Acquired with a Remidio smartphone fundus camera
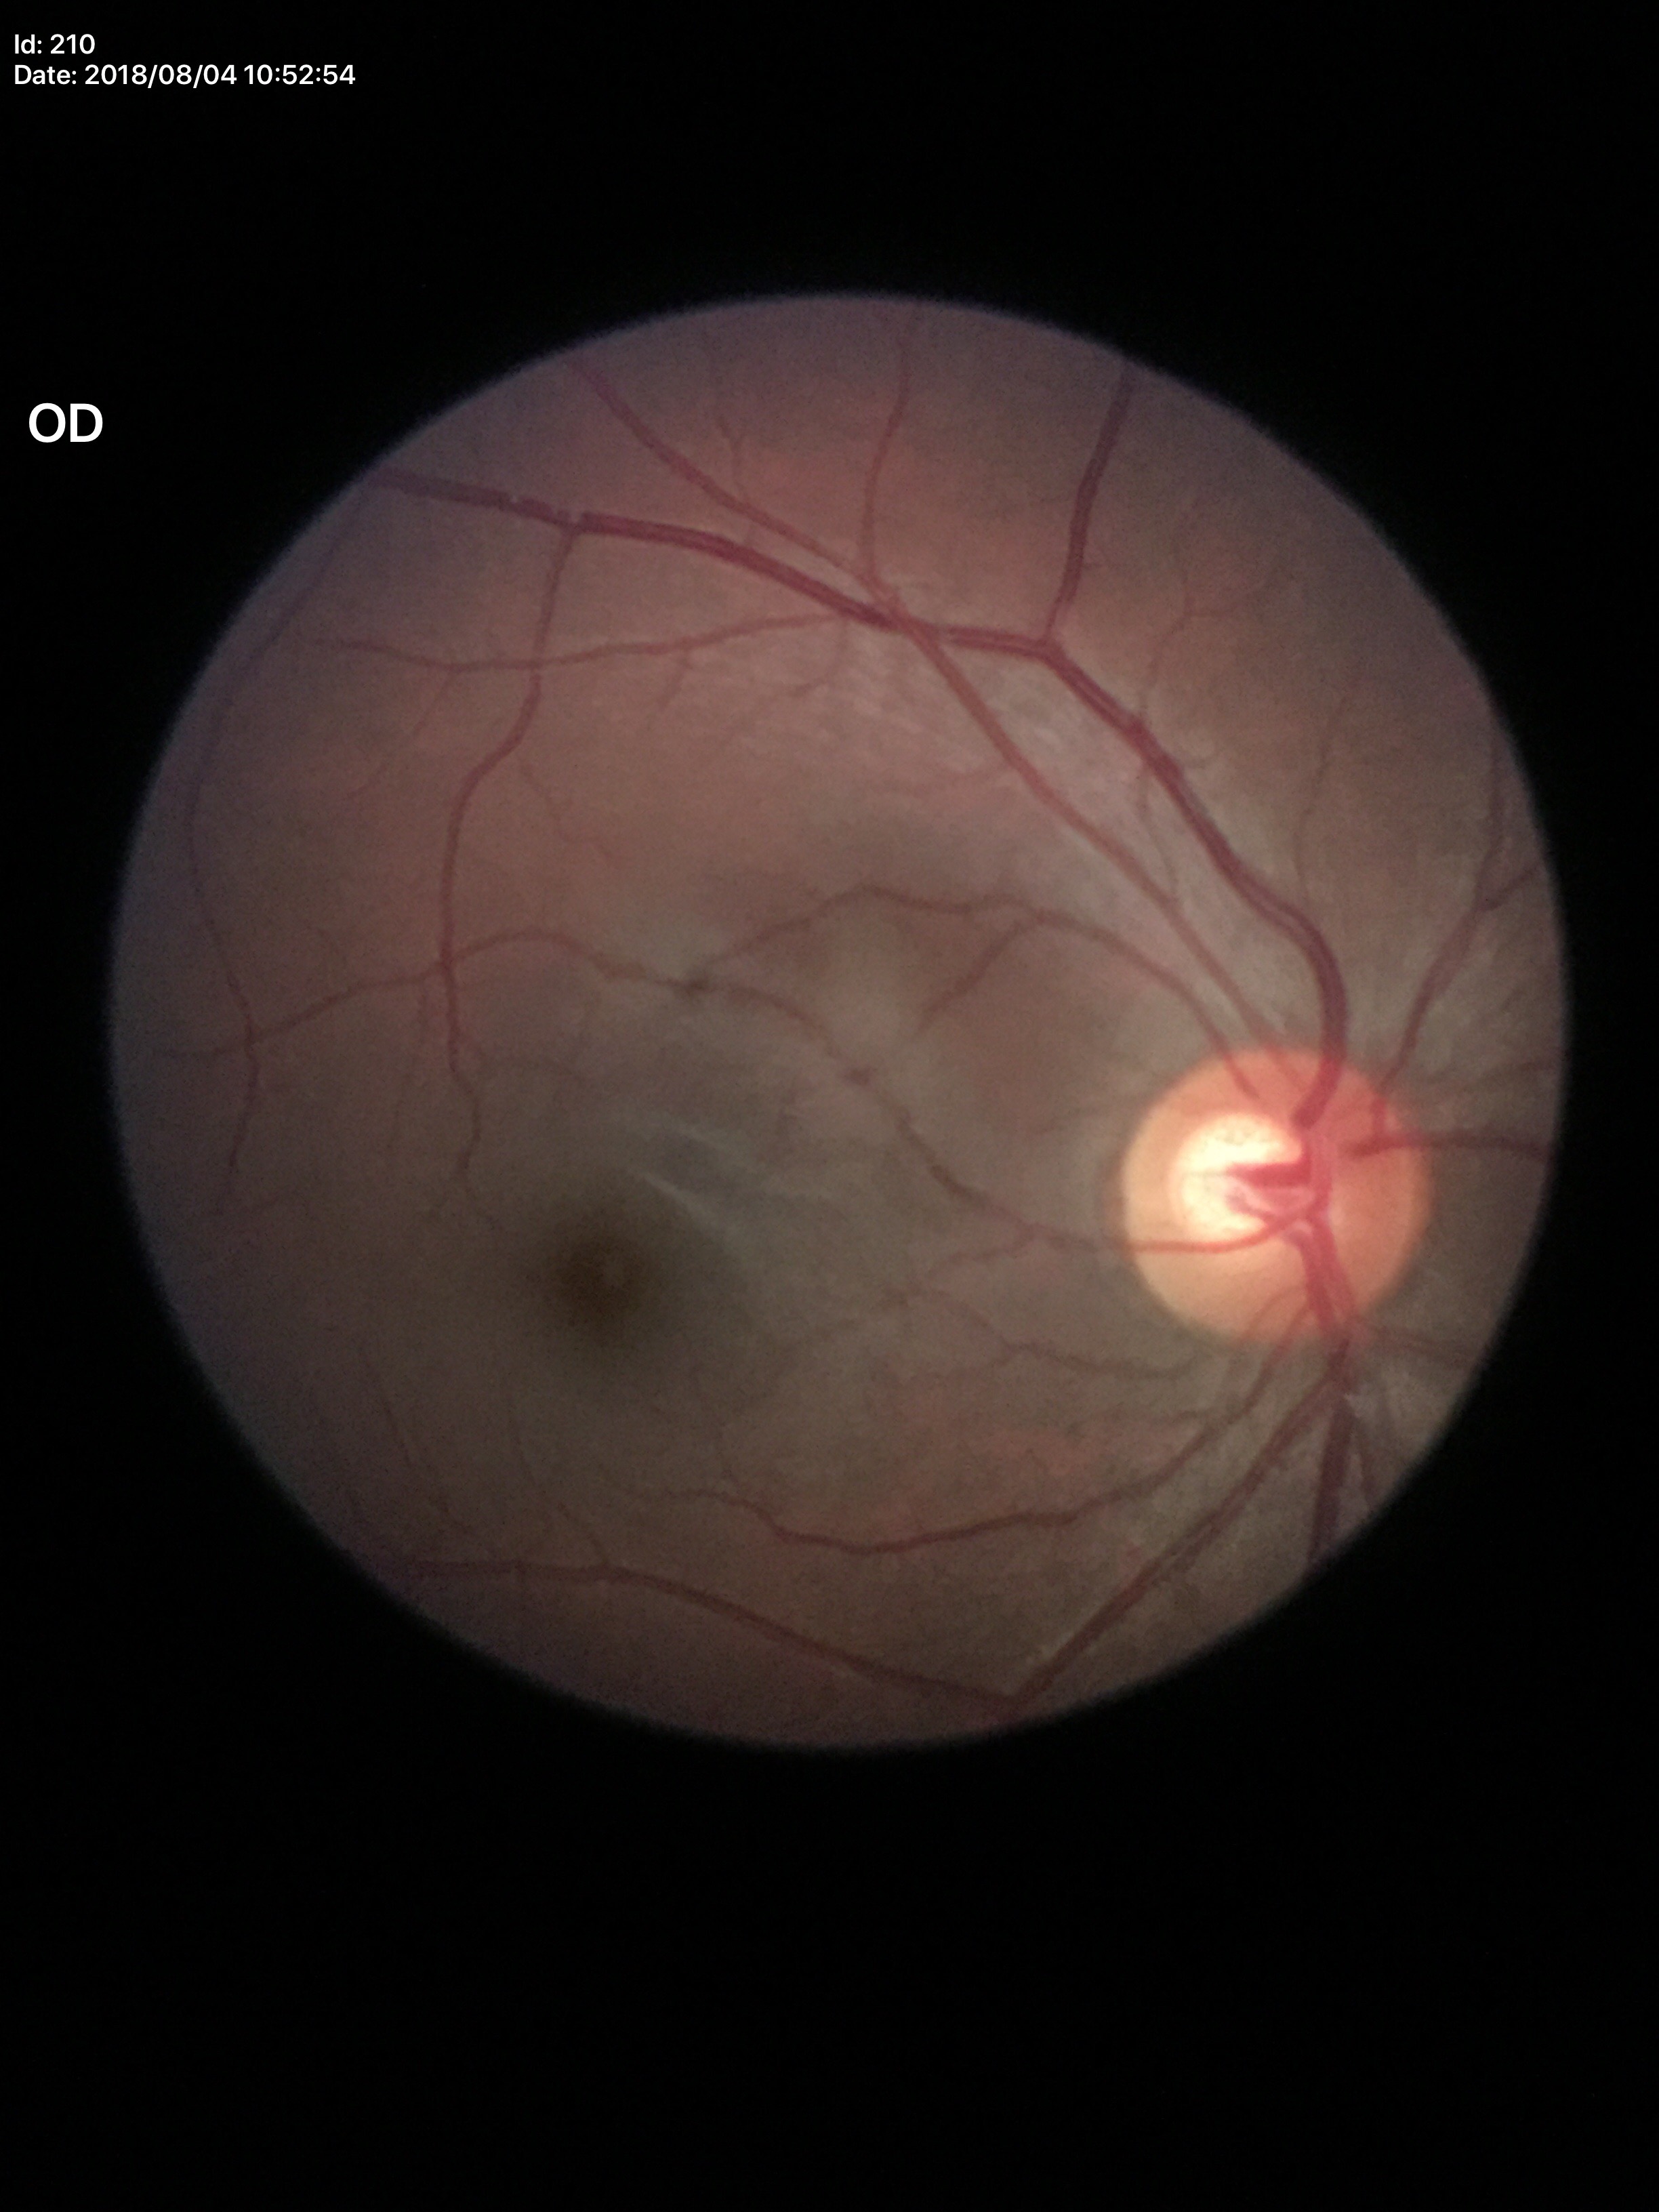 Q: What is the VCDR?
A: 0.56
Q: Horizontal CDR?
A: 0.59
Q: Is there glaucoma suspicion?
A: not suspect